Color fundus image. 45° FOV. 848 by 848 pixels. Nonmydriatic fundus photograph. Modified Davis classification. NIDEK AFC-230 fundus camera — 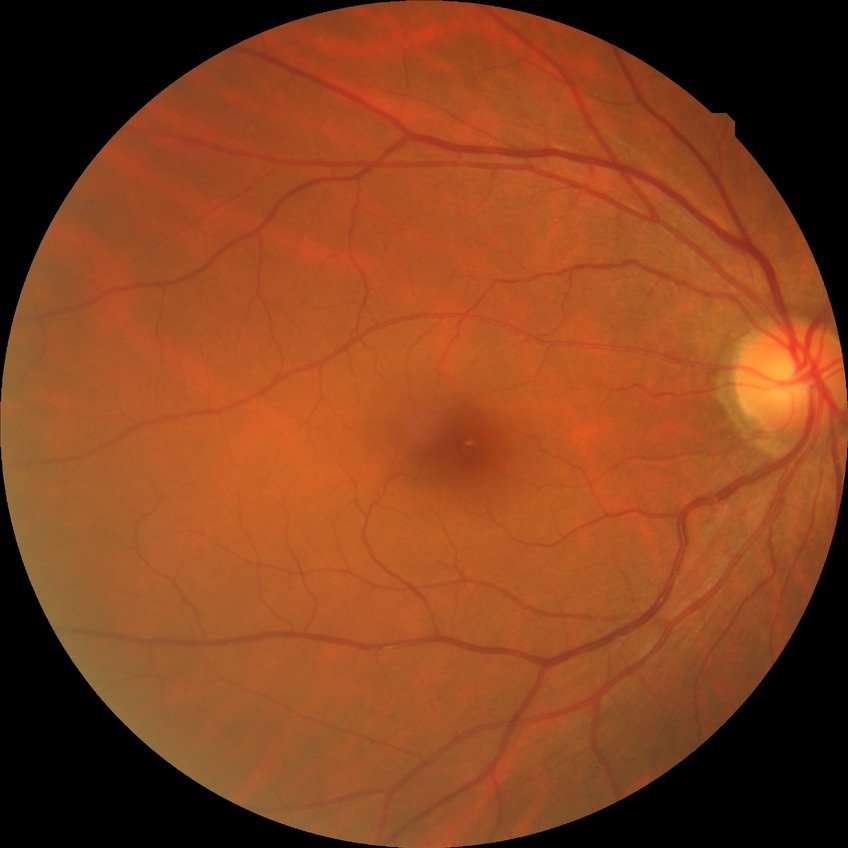
Diabetic retinopathy (DR): no diabetic retinopathy (NDR).